DR severity per modified Davis staging, retinal fundus photograph — 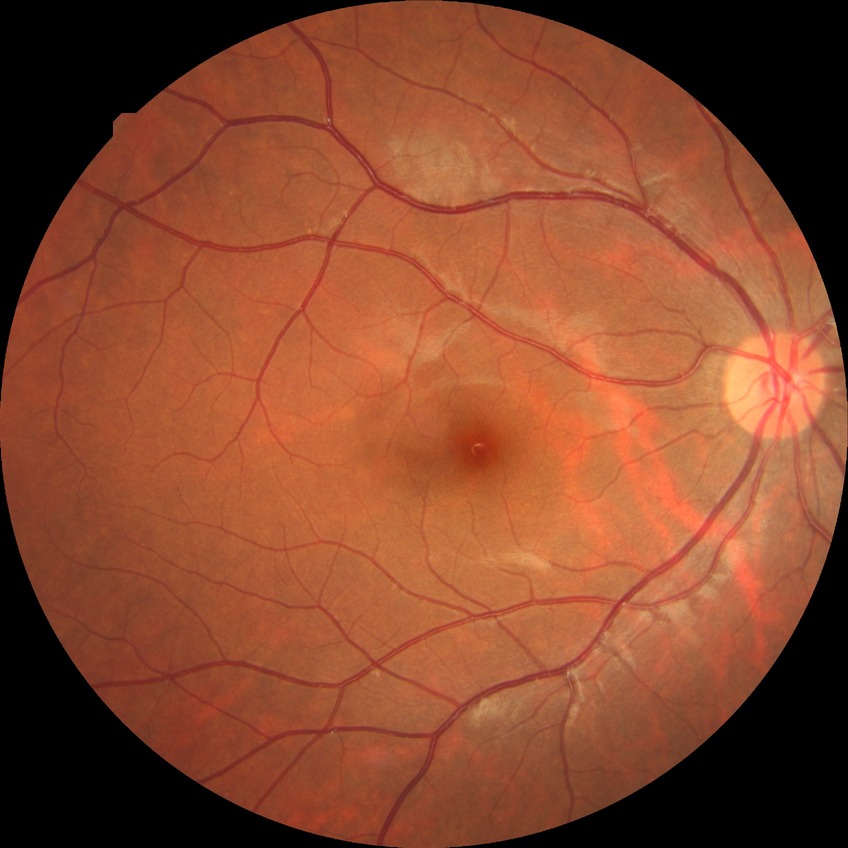
Retinopathy stage is no diabetic retinopathy.